2346 x 1568 pixels, FOV: 45 degrees, color fundus photograph
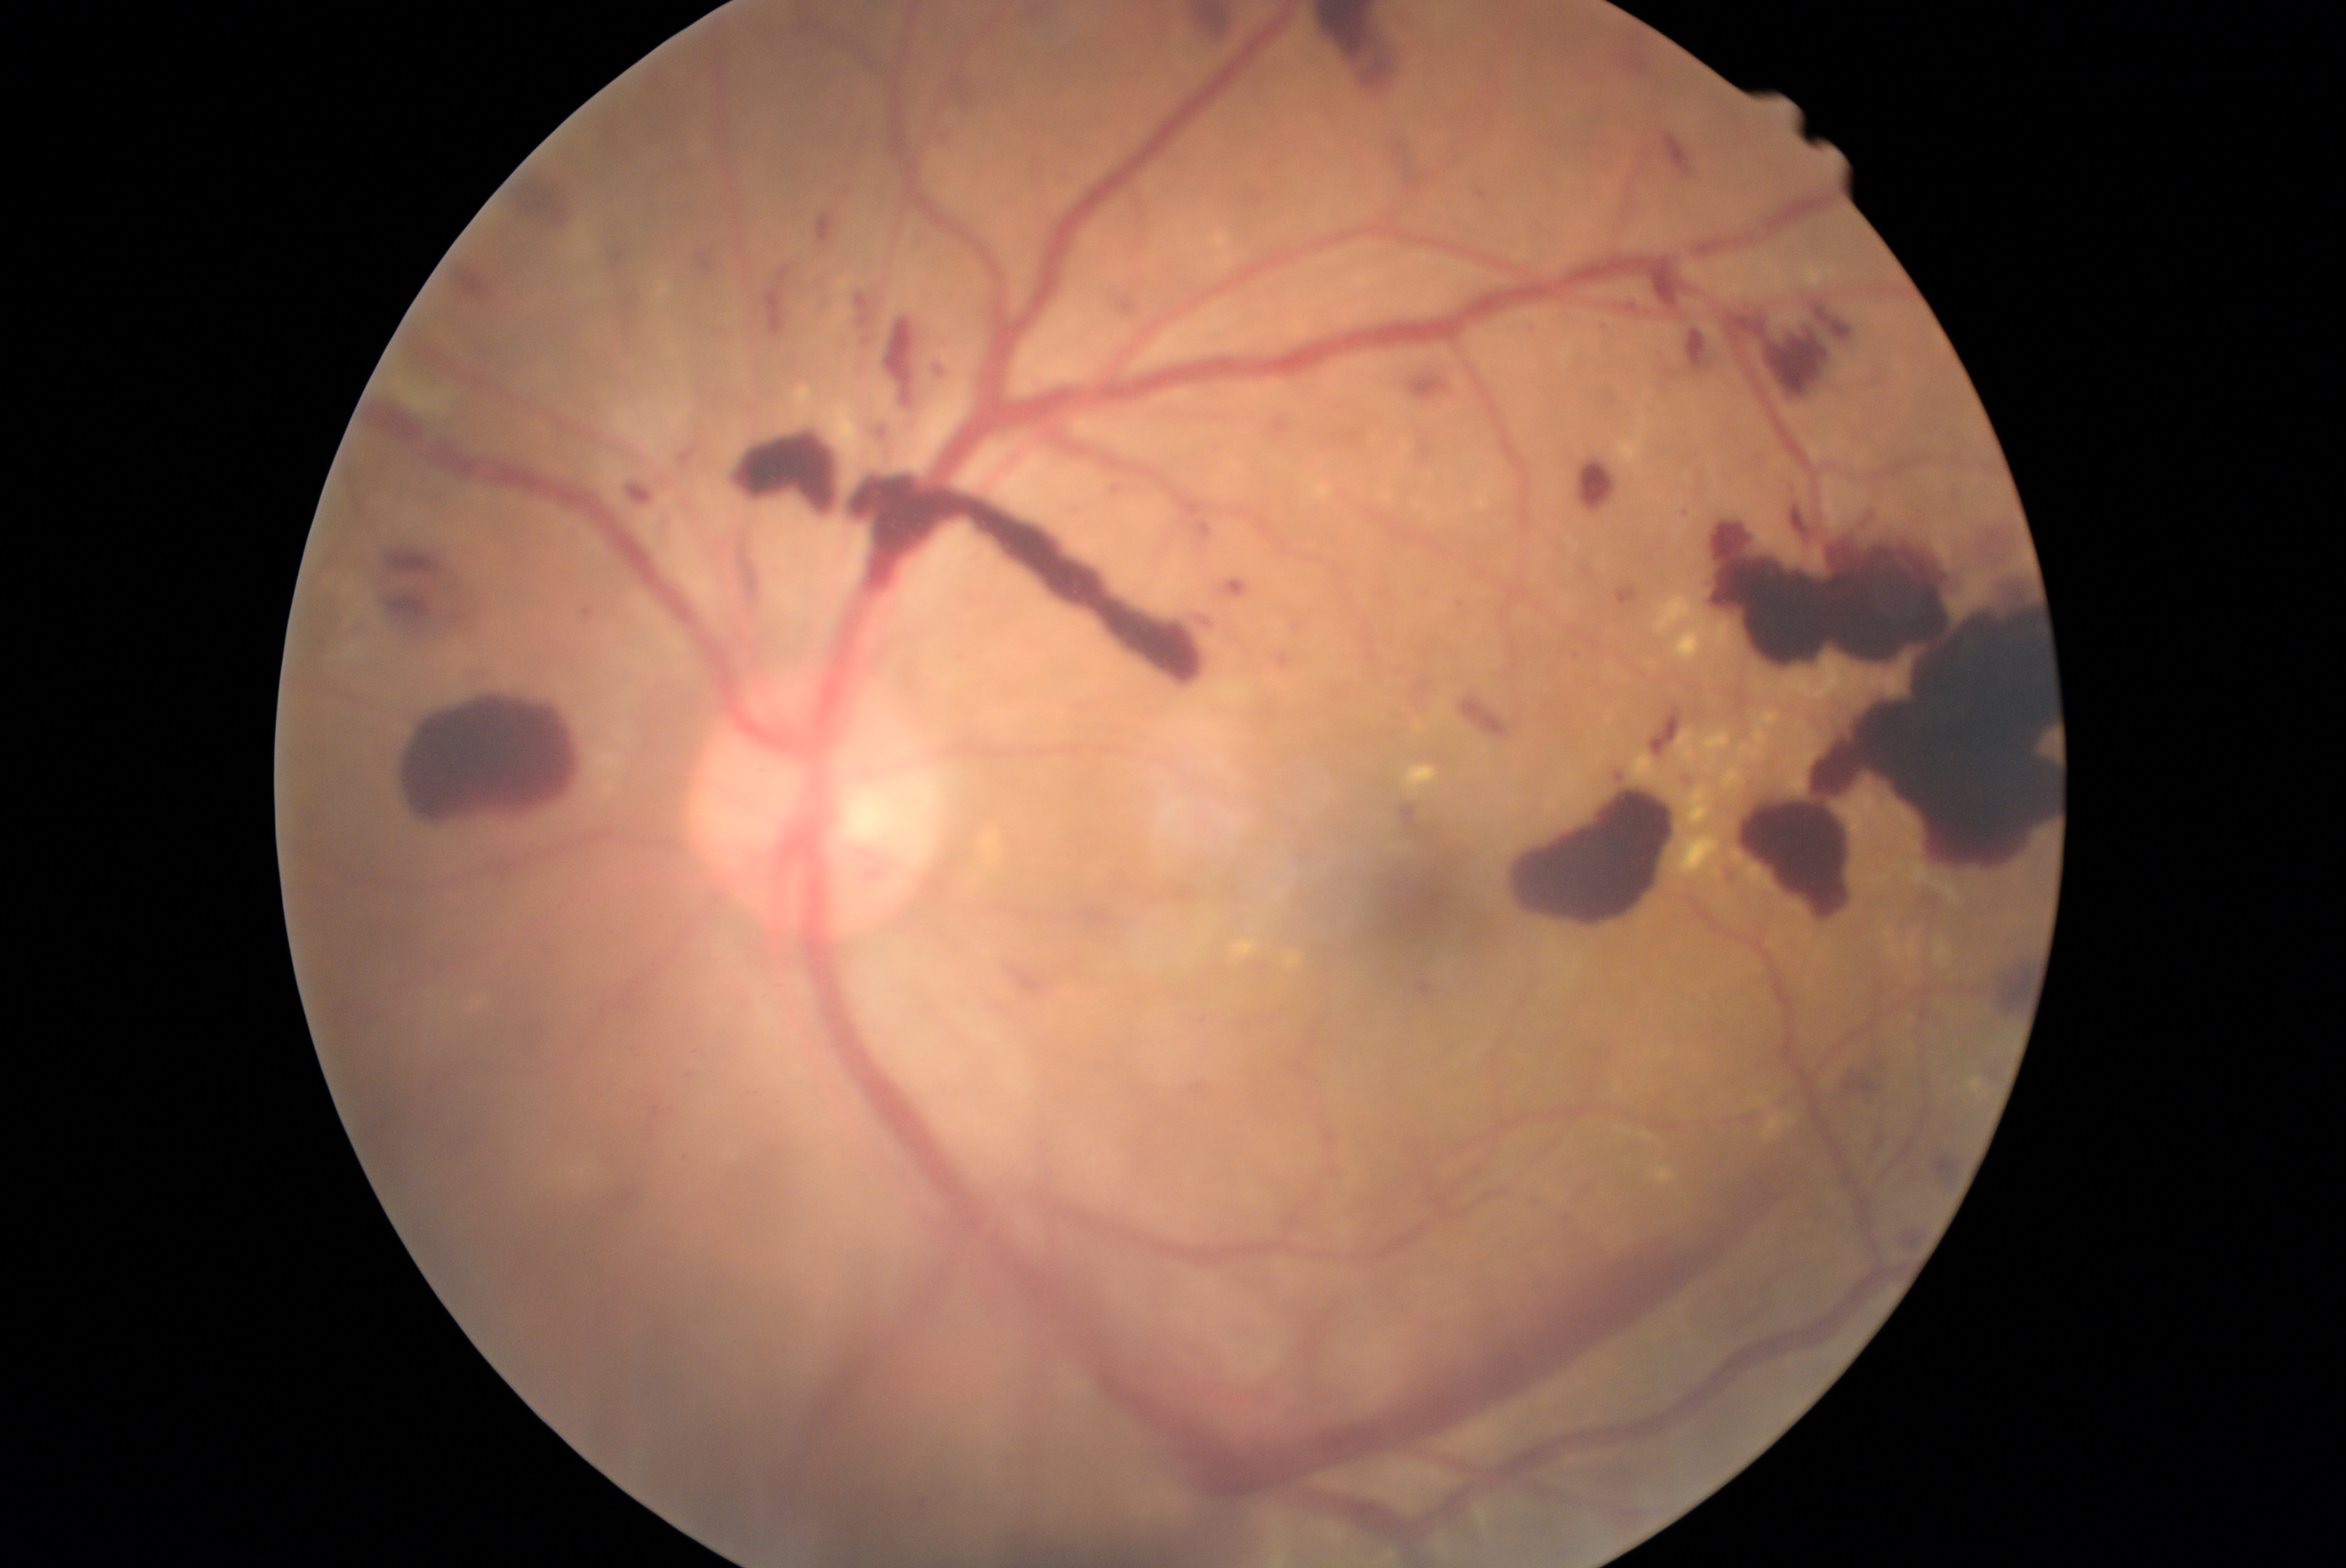

Diabetic retinopathy (DR): grade 4 (PDR)
A subset of detected lesions:
• hemorrhages (HEs) (subset): bbox(1226, 581, 1249, 598) | bbox(837, 184, 860, 205) | bbox(1619, 300, 1643, 311) | bbox(1178, 1, 1243, 56) | bbox(452, 263, 496, 311) | bbox(854, 291, 873, 333) | bbox(520, 175, 576, 234) | bbox(1652, 710, 1680, 752) | bbox(929, 360, 948, 387) | bbox(851, 363, 865, 376) | bbox(1931, 1155, 1959, 1188) | bbox(1580, 462, 1616, 512) | bbox(865, 419, 899, 452) | bbox(1558, 642, 1588, 666) | bbox(1520, 319, 1539, 335) | bbox(369, 540, 495, 652) | bbox(1502, 785, 1676, 927) | bbox(1103, 280, 1142, 318)